45° field of view. Retinal fundus photograph. 2184 x 1682 pixels
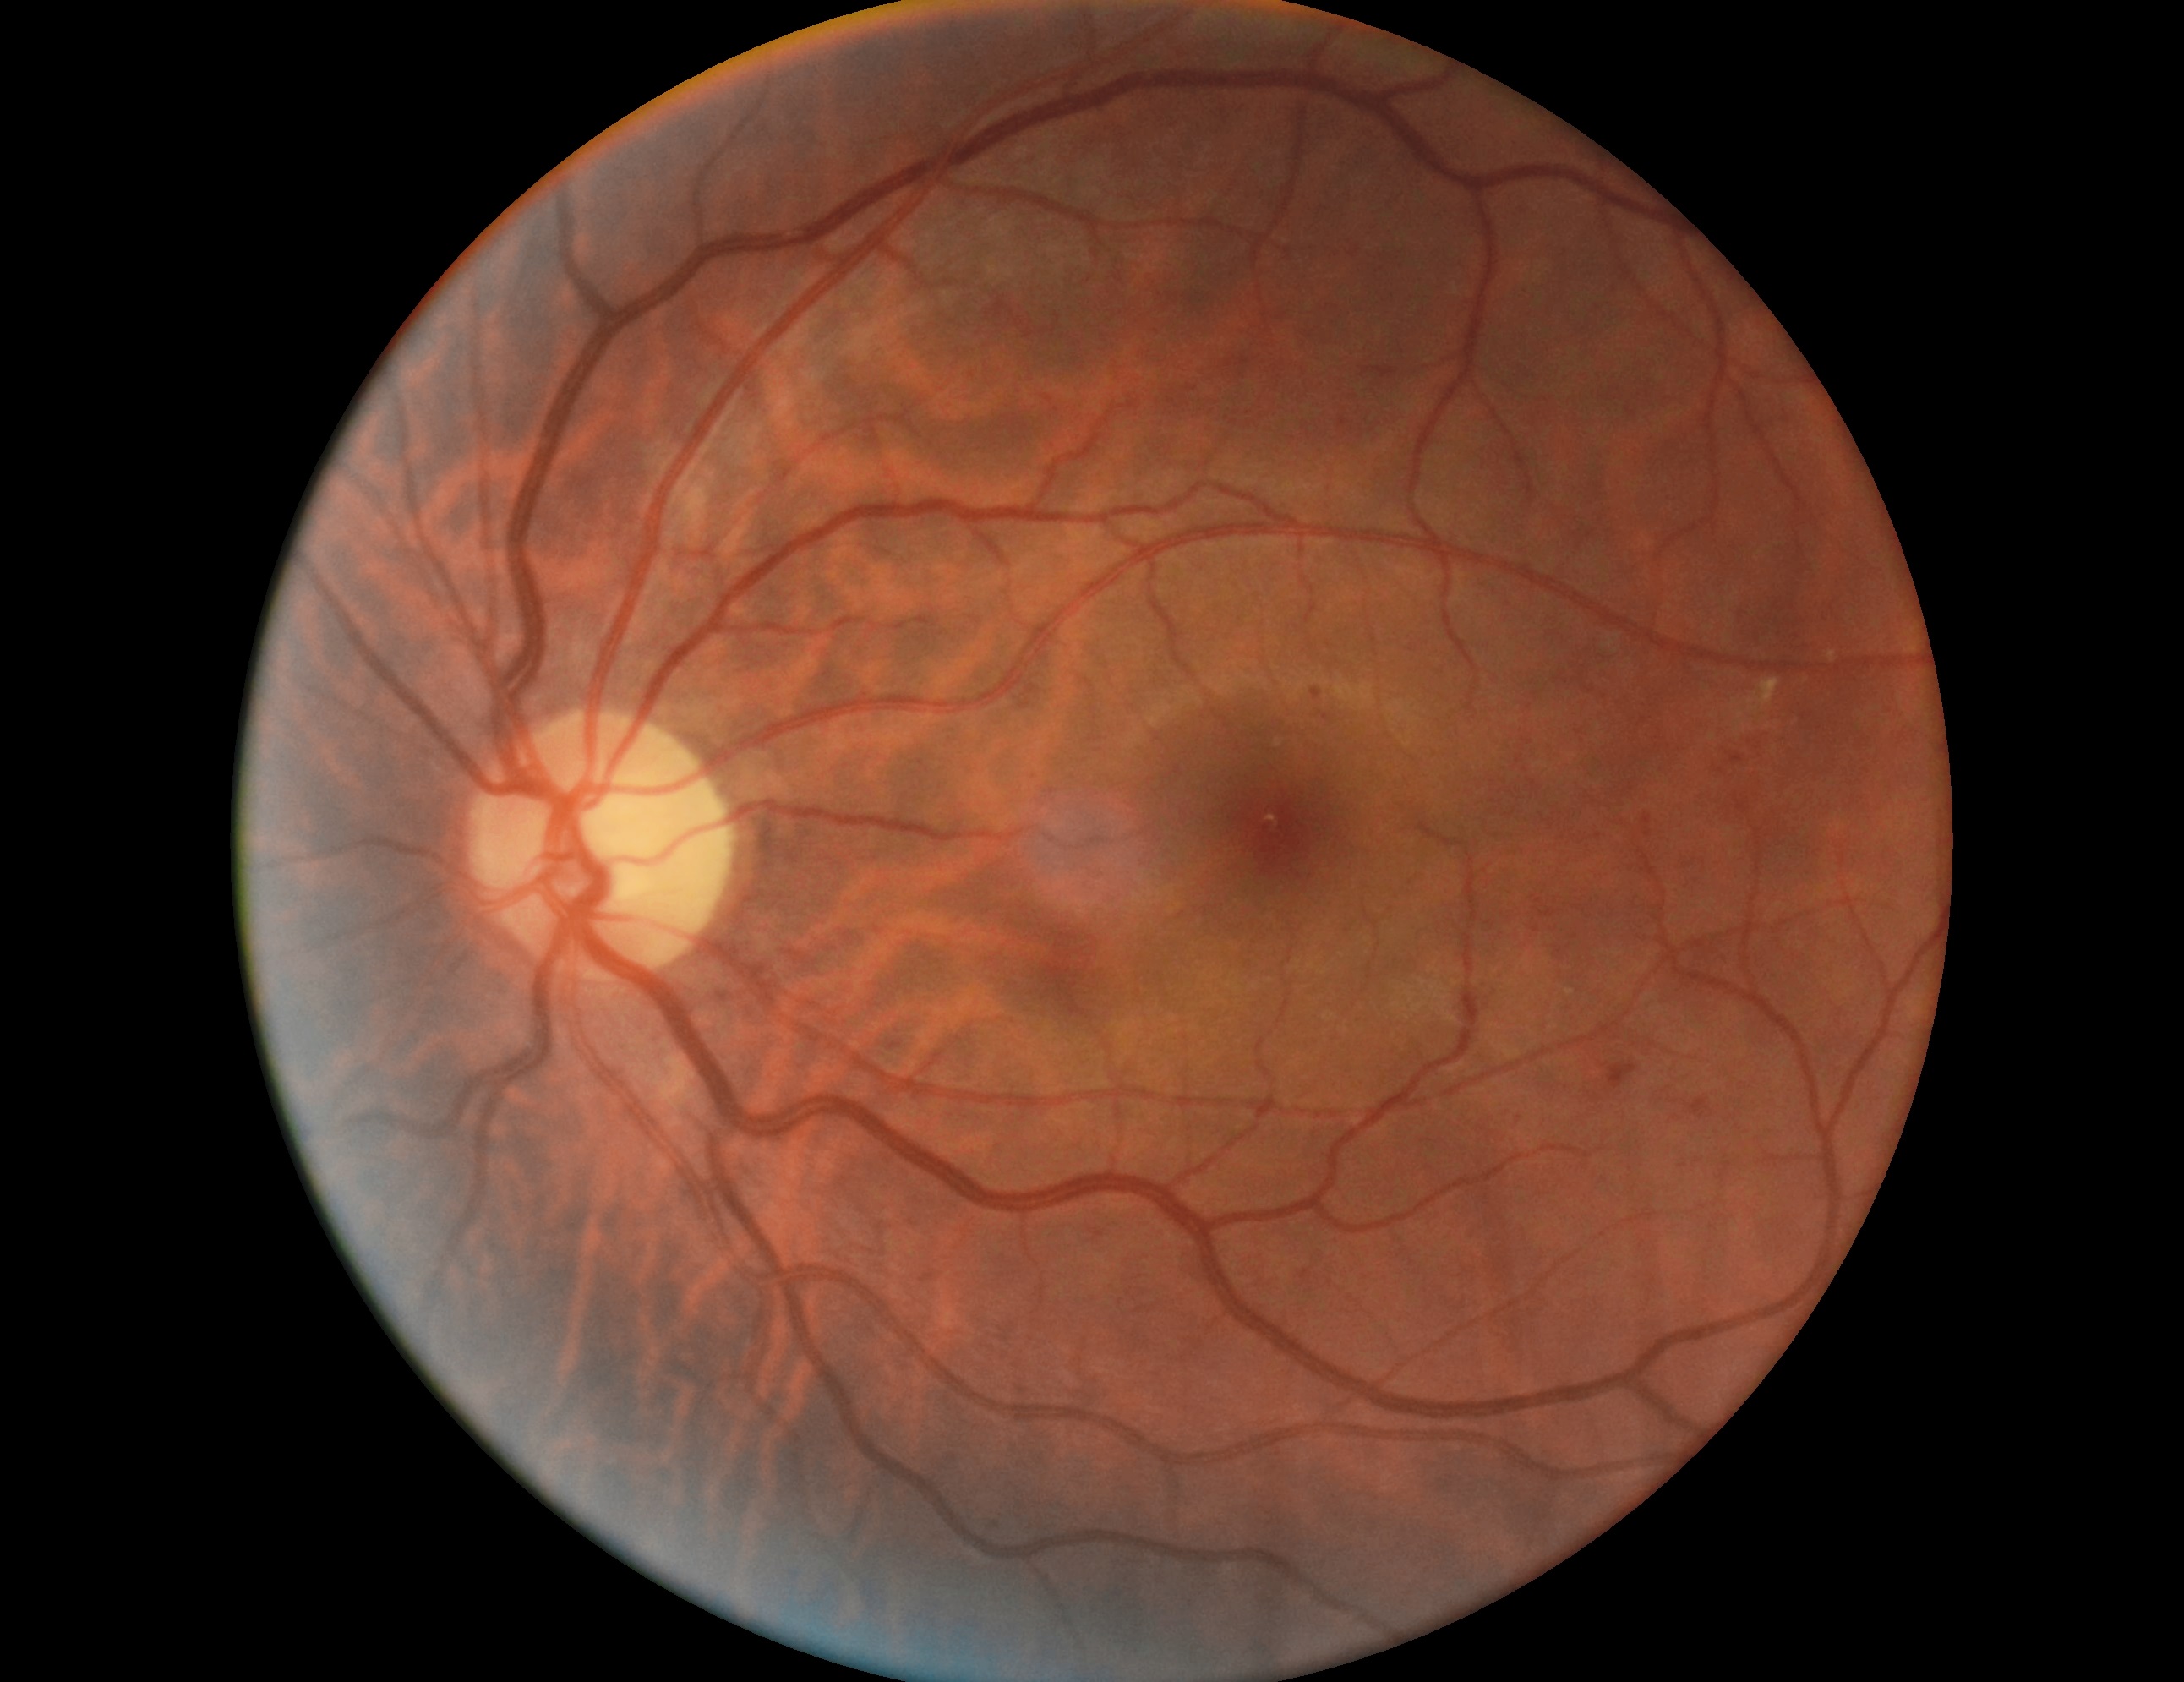
Retinopathy grade: moderate NPDR (2).